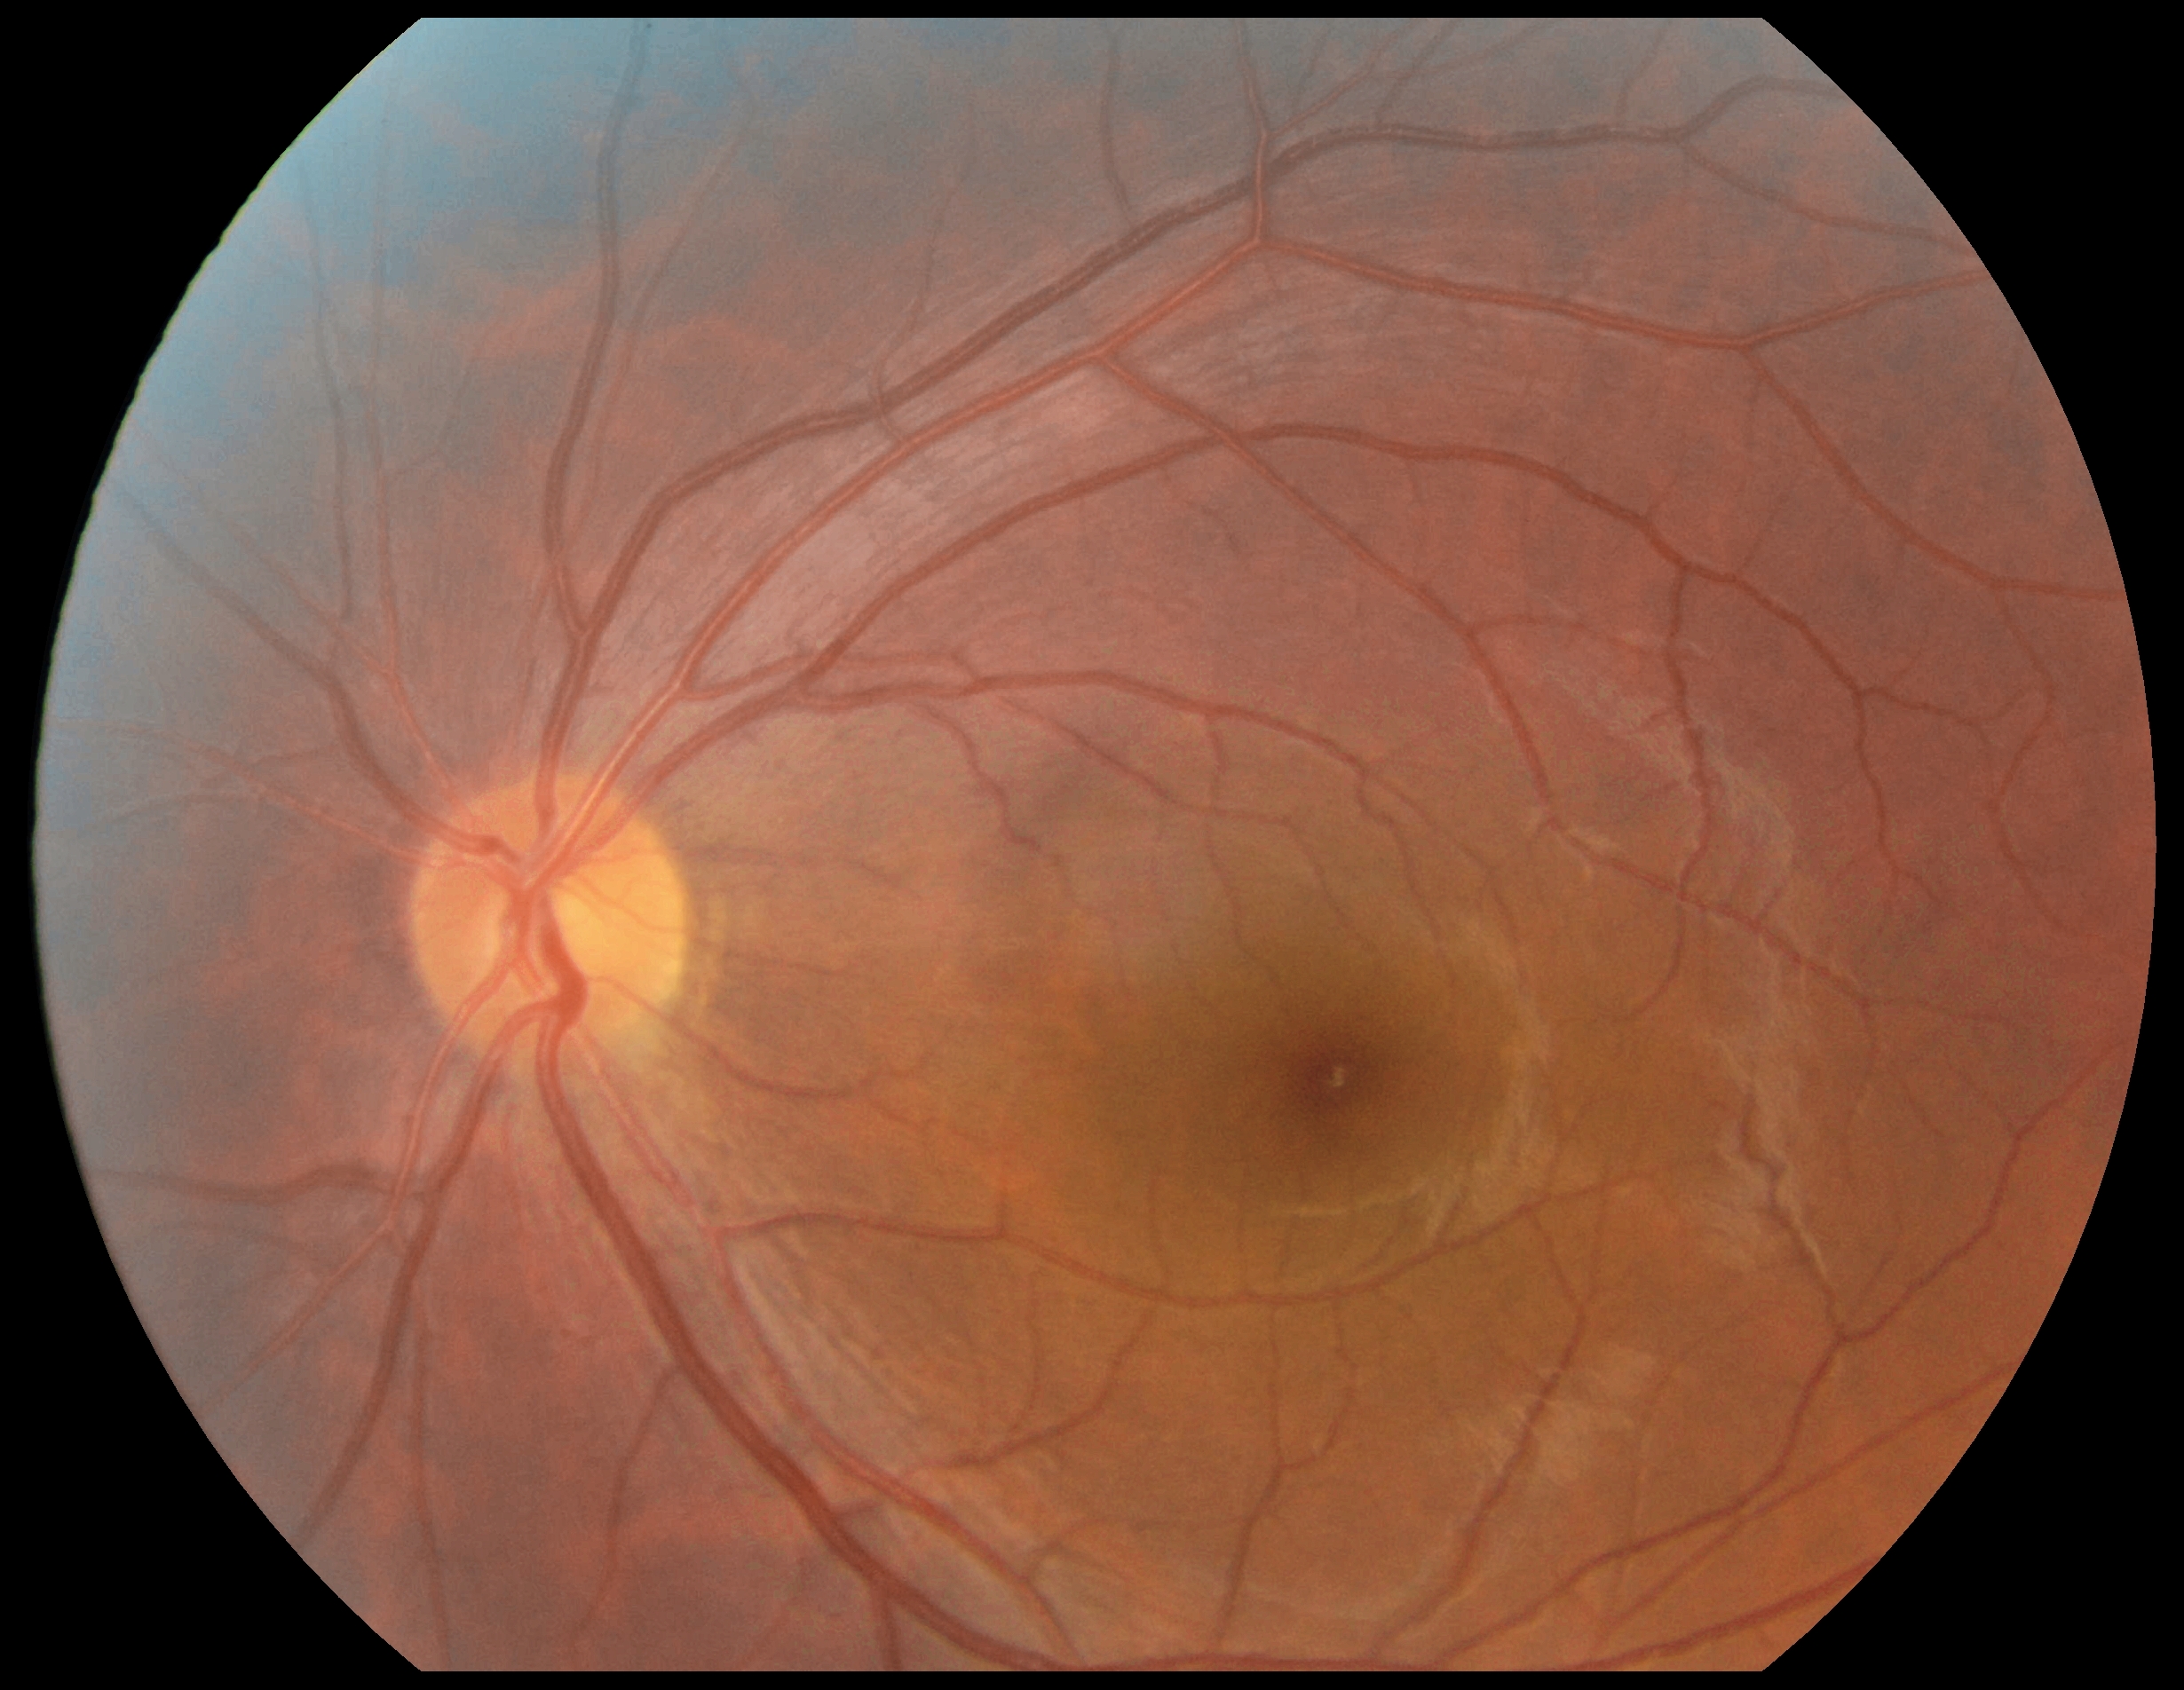

DR stage = grade 0 (no apparent retinopathy).